45° field of view. Color fundus photograph
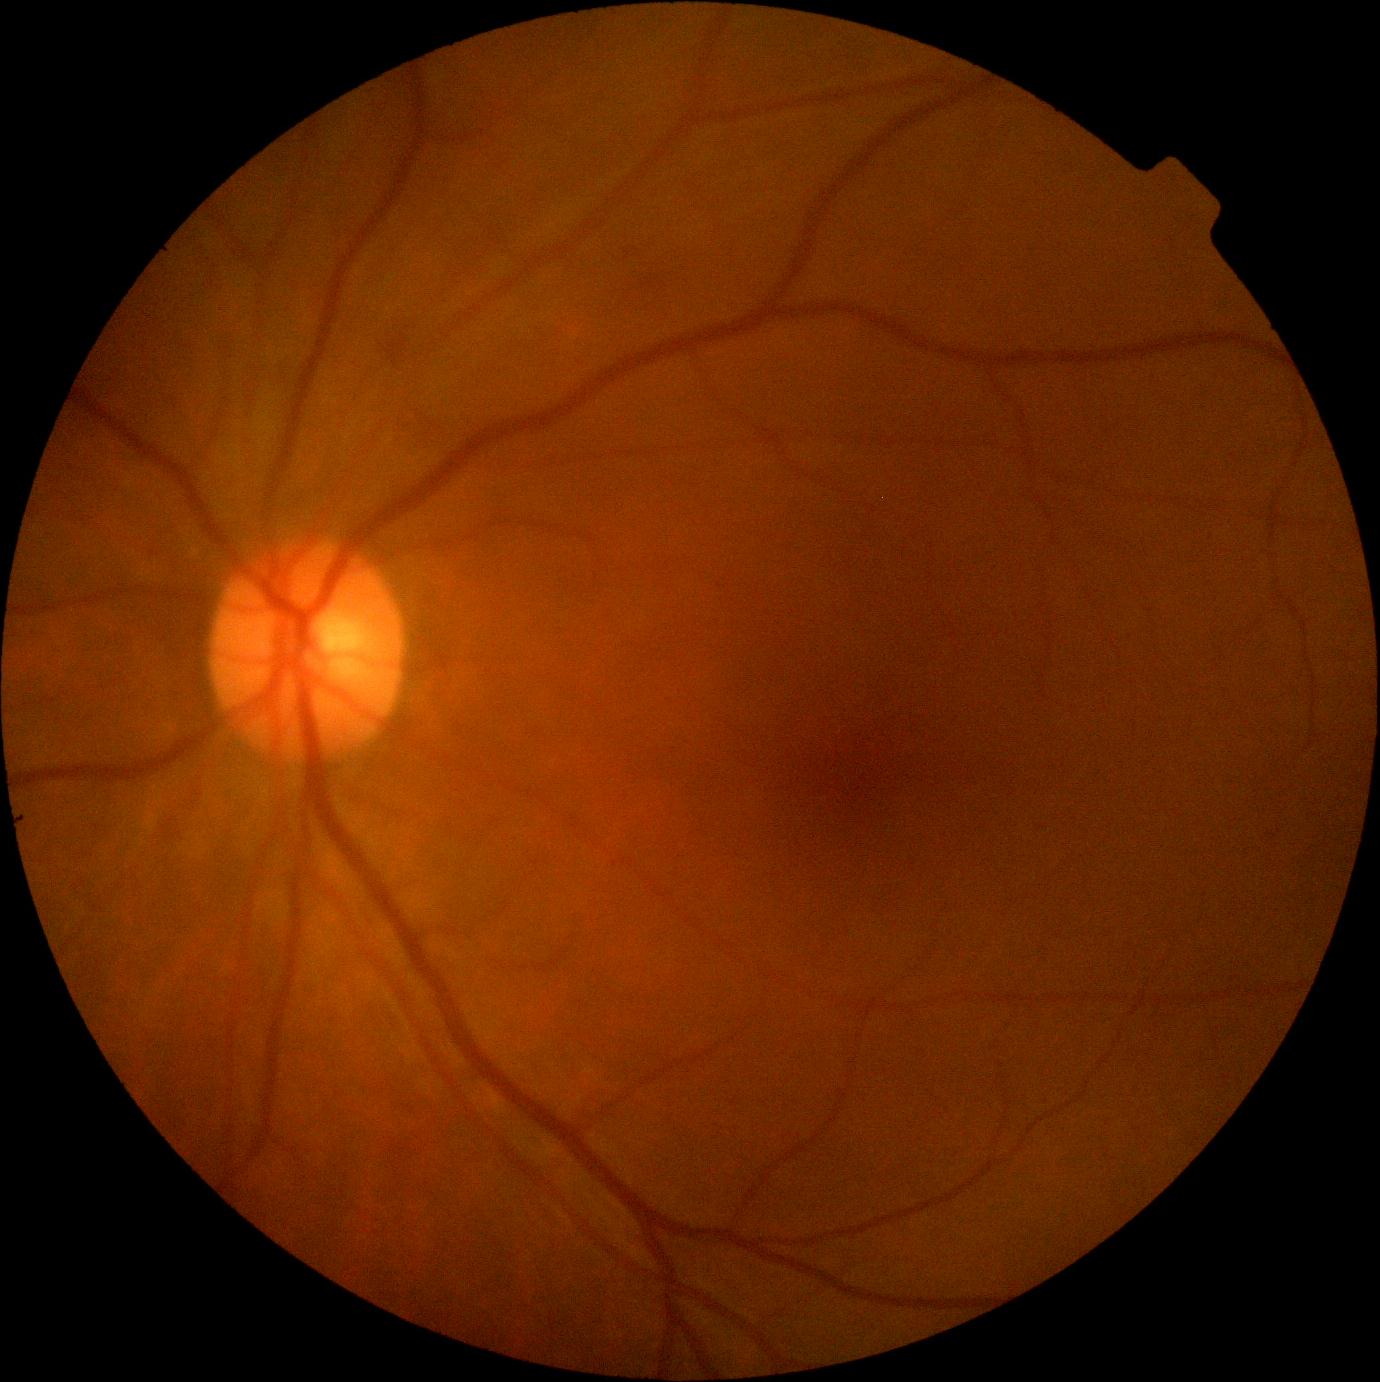
DR impression = no DR findings | DR grade = no apparent diabetic retinopathy (0).